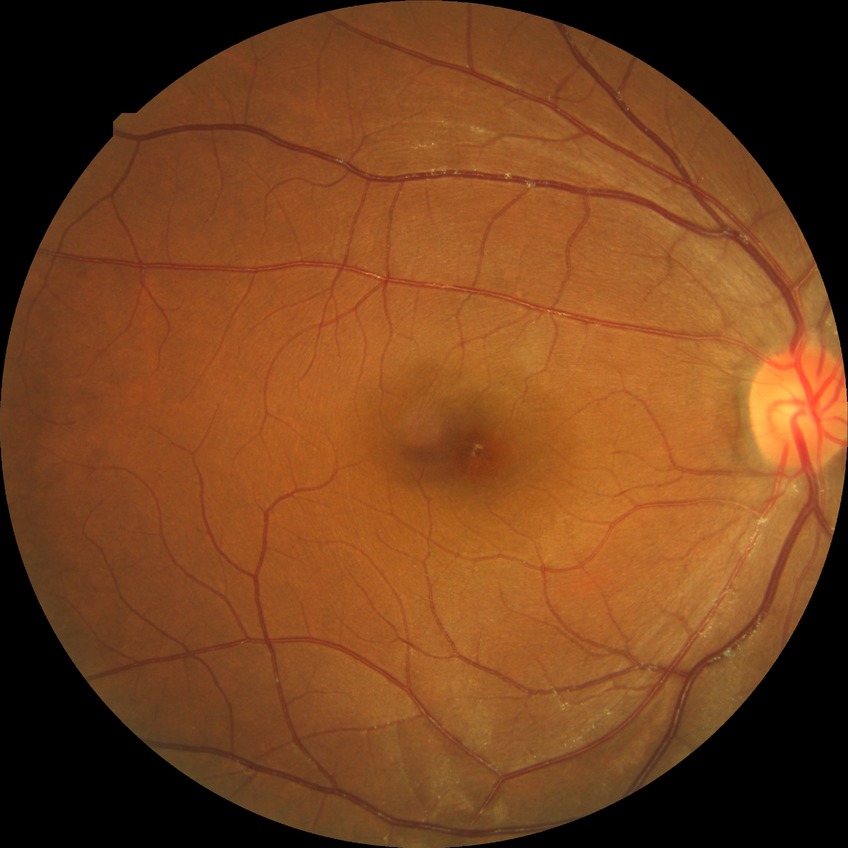
Diabetic retinopathy severity: no diabetic retinopathy.